Infant wide-field fundus photograph
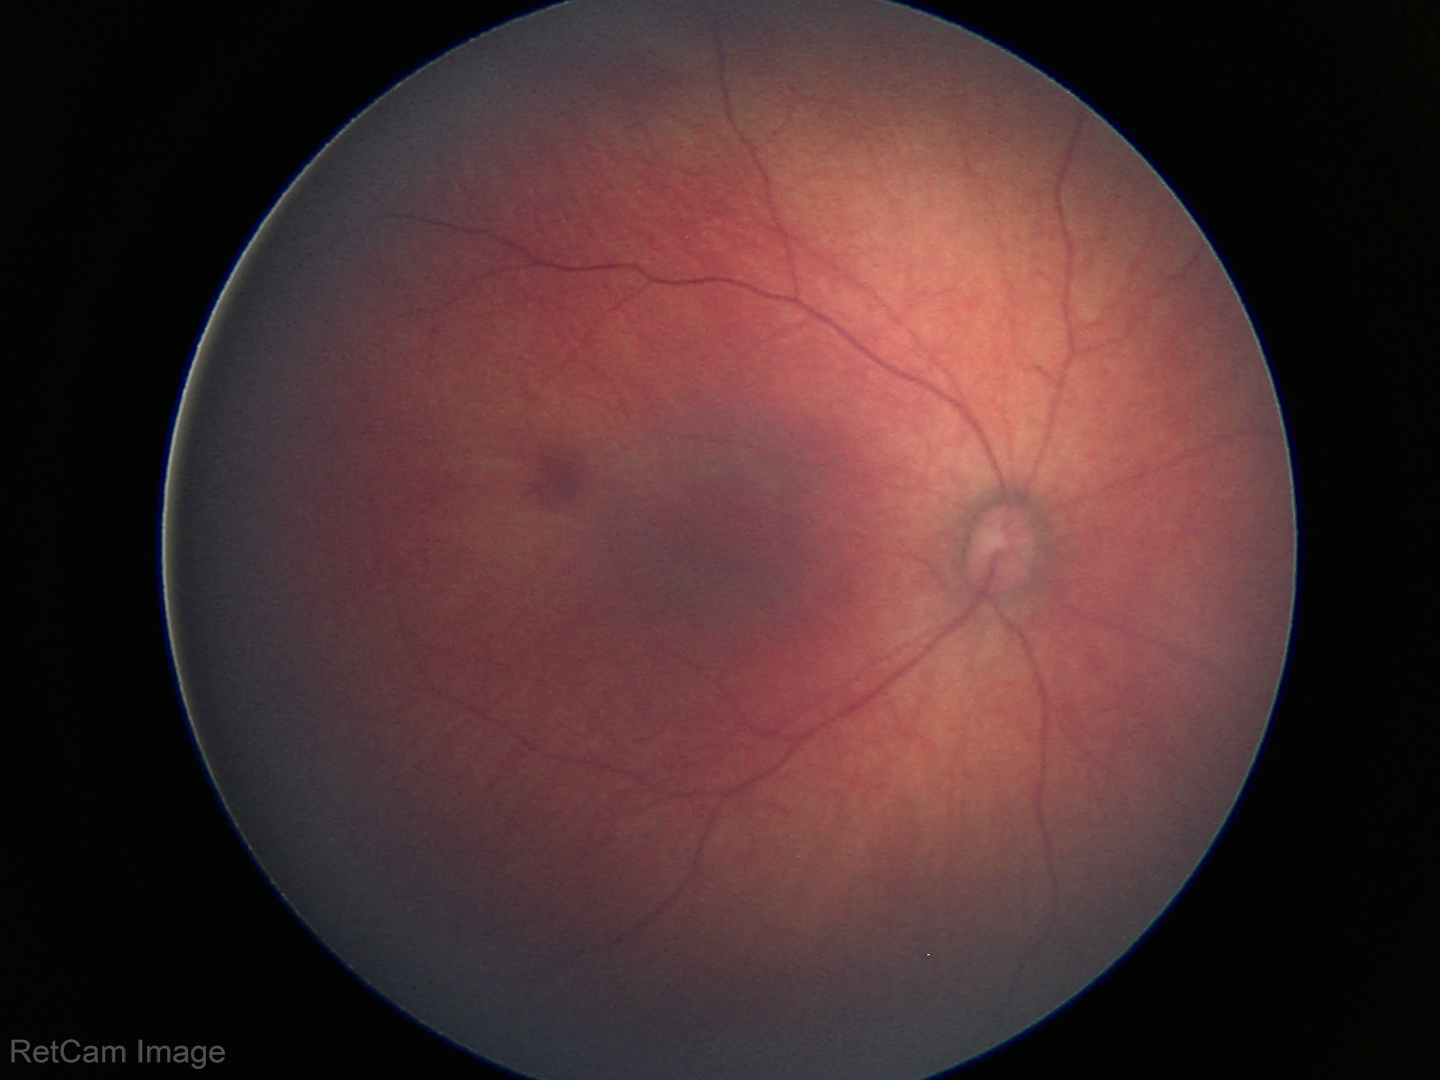
Screening: normal retinal appearance.